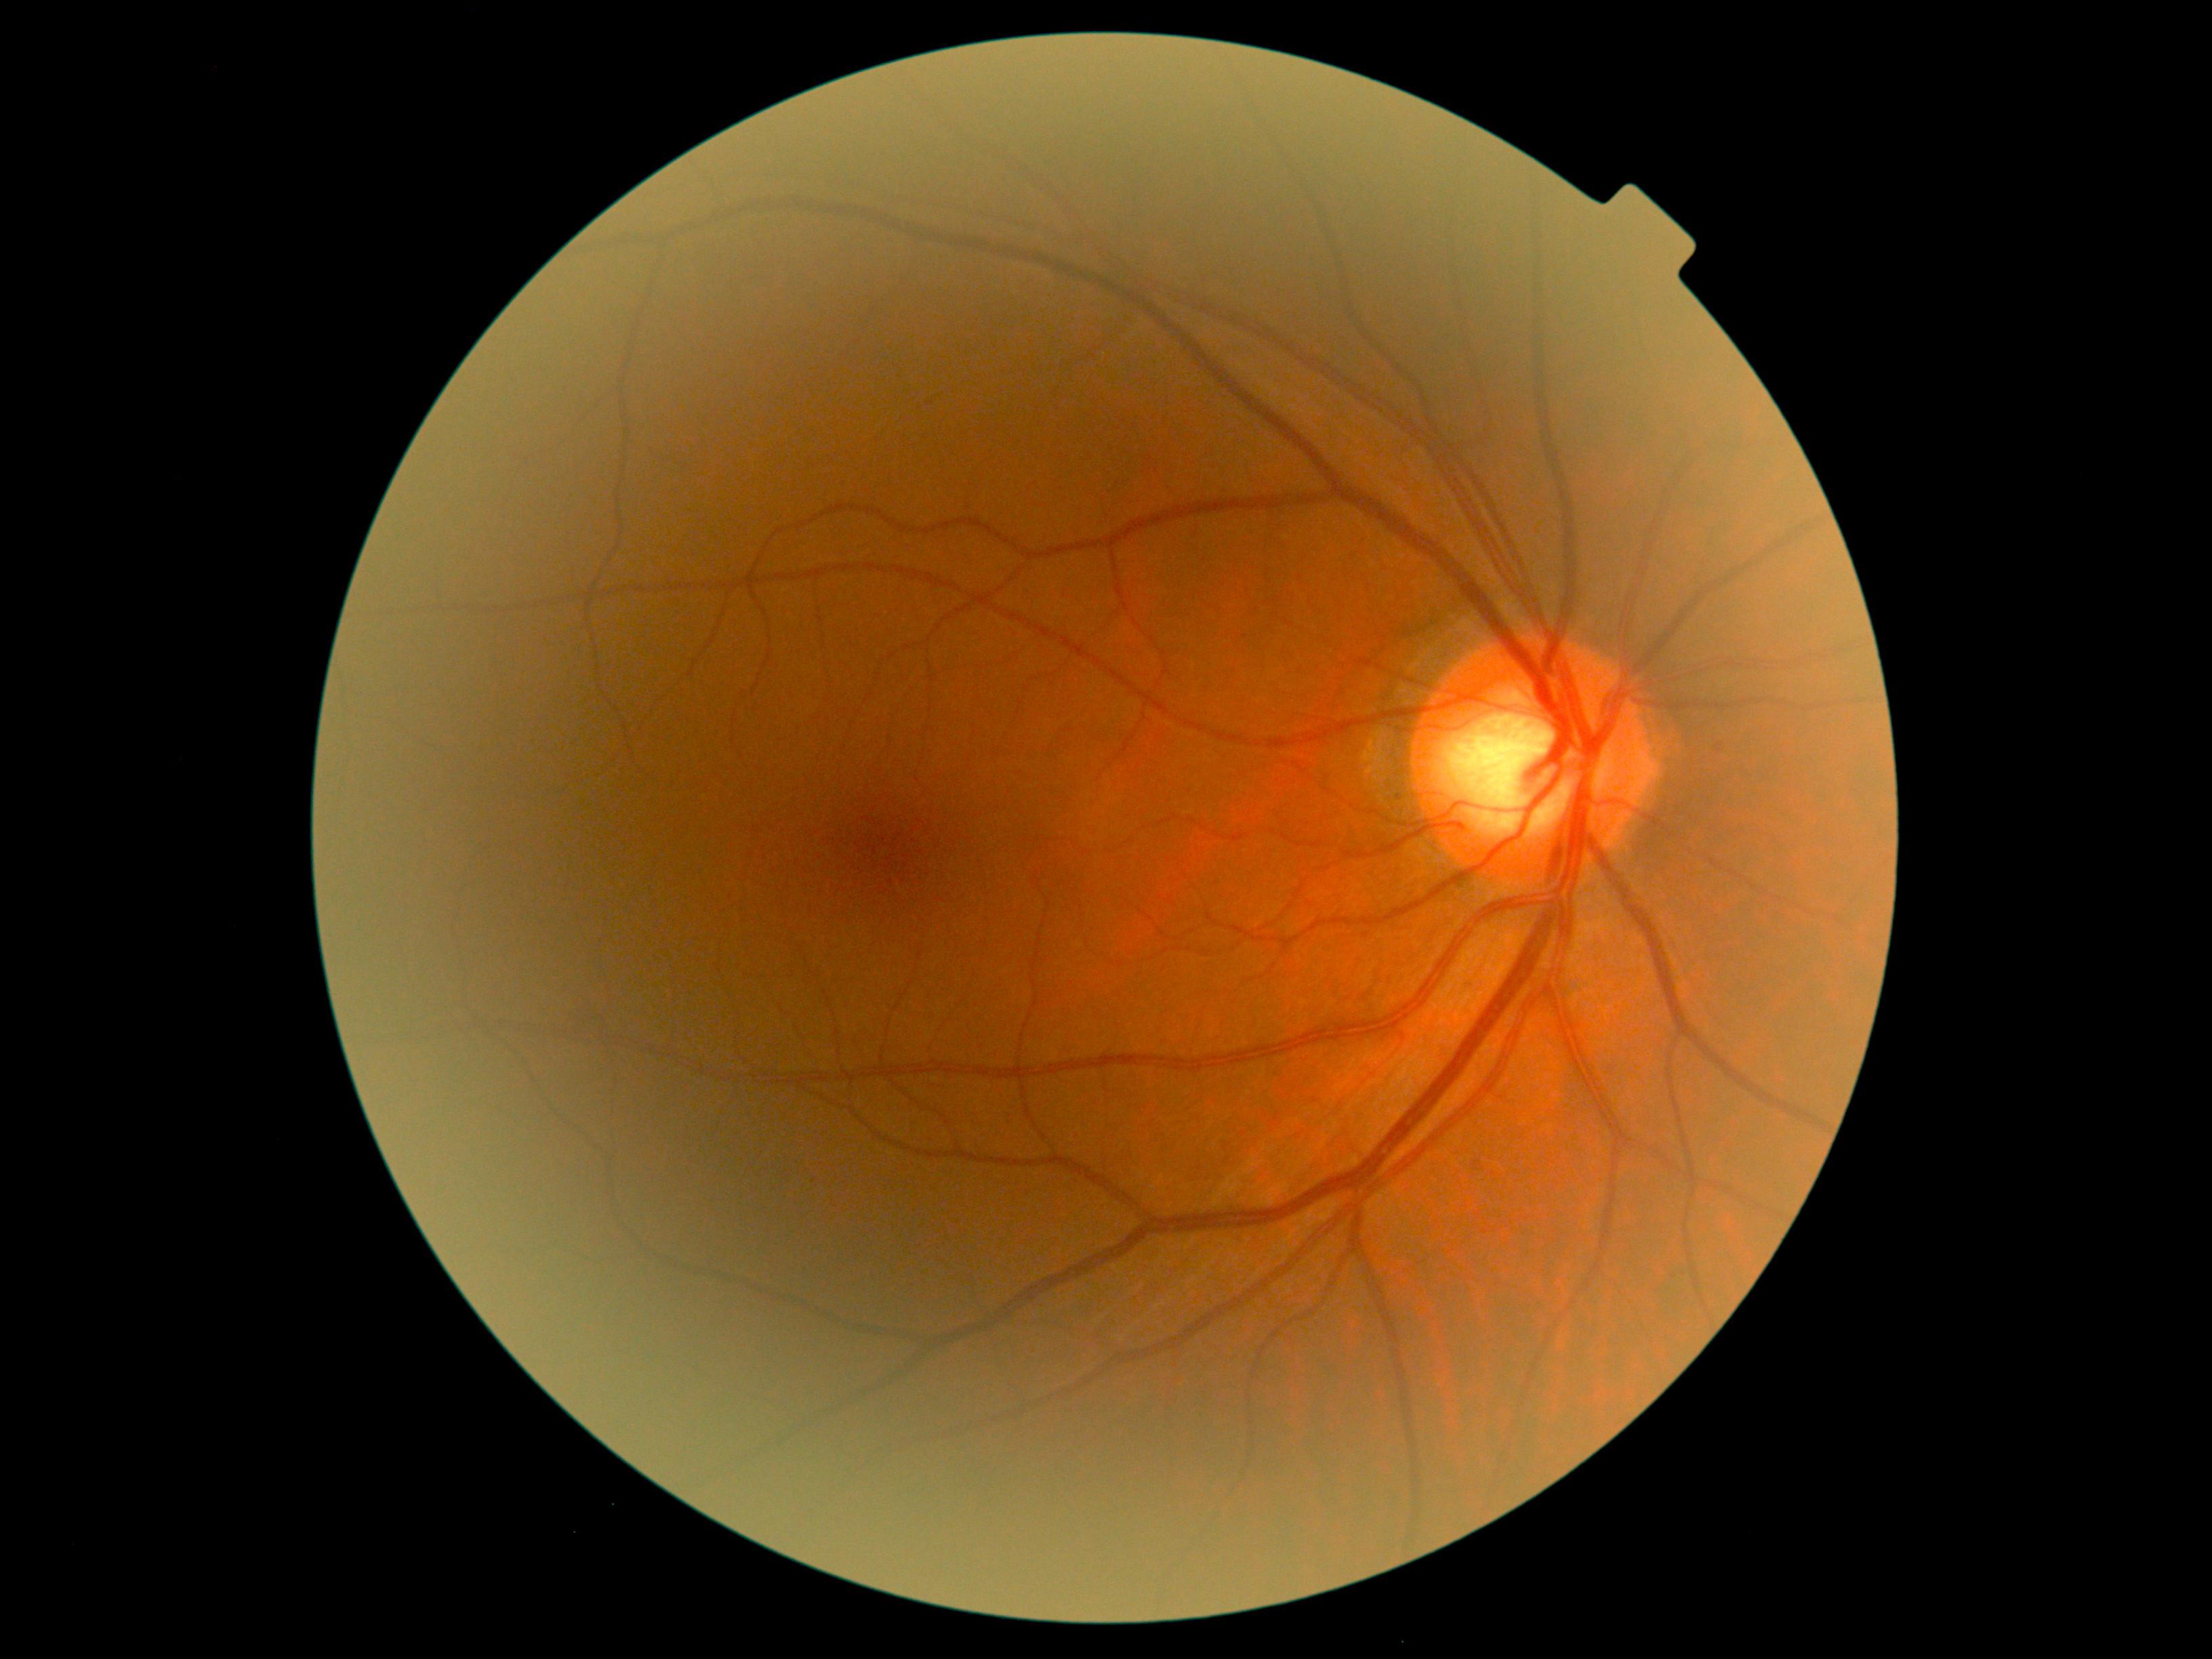
DR severity is 0 — no visible signs of diabetic retinopathy.